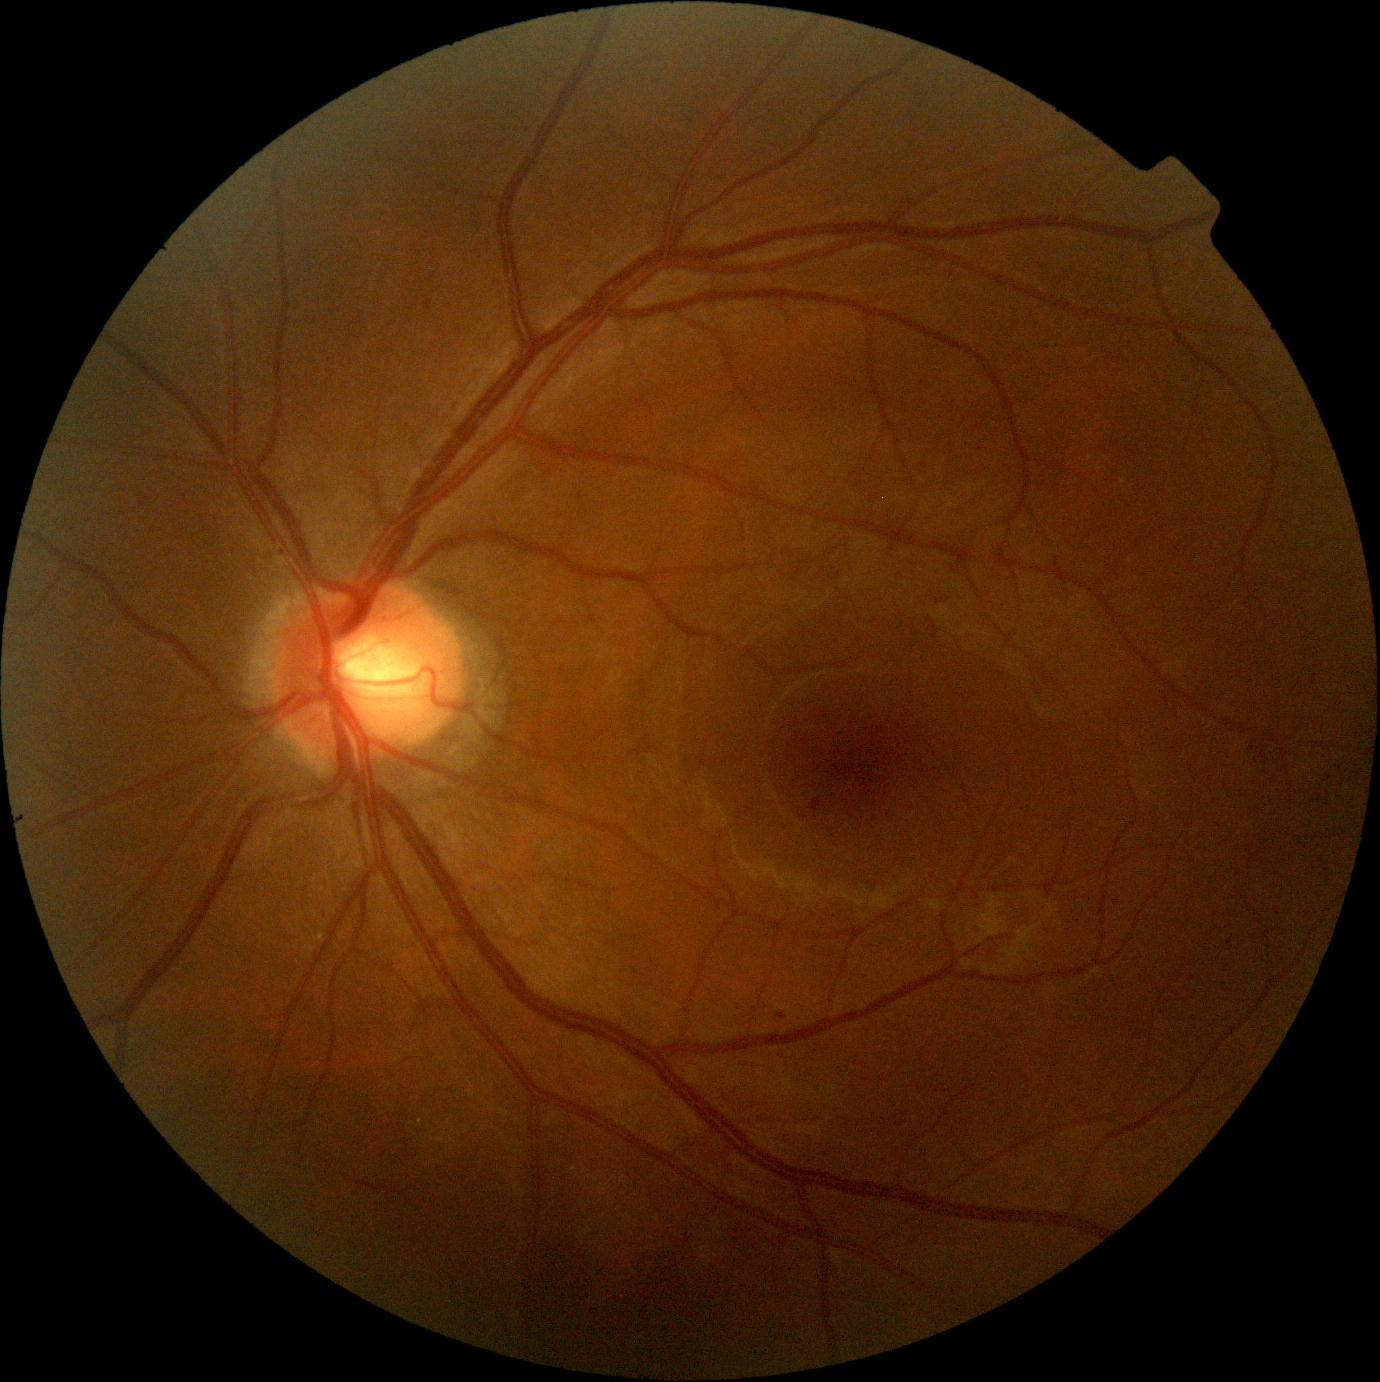

Diabetic retinopathy (DR) is grade 1 (mild NPDR). No hemorrhages (HEs) identified. No hard exudates (EXs) identified. No soft exudates (SEs) identified. Microaneurysms (MAs) present at left=1228, top=936, right=1234, bottom=946; left=809, top=799, right=822, bottom=814; left=425, top=300, right=433, bottom=310. Smaller MAs around 782/1017; 922/384.